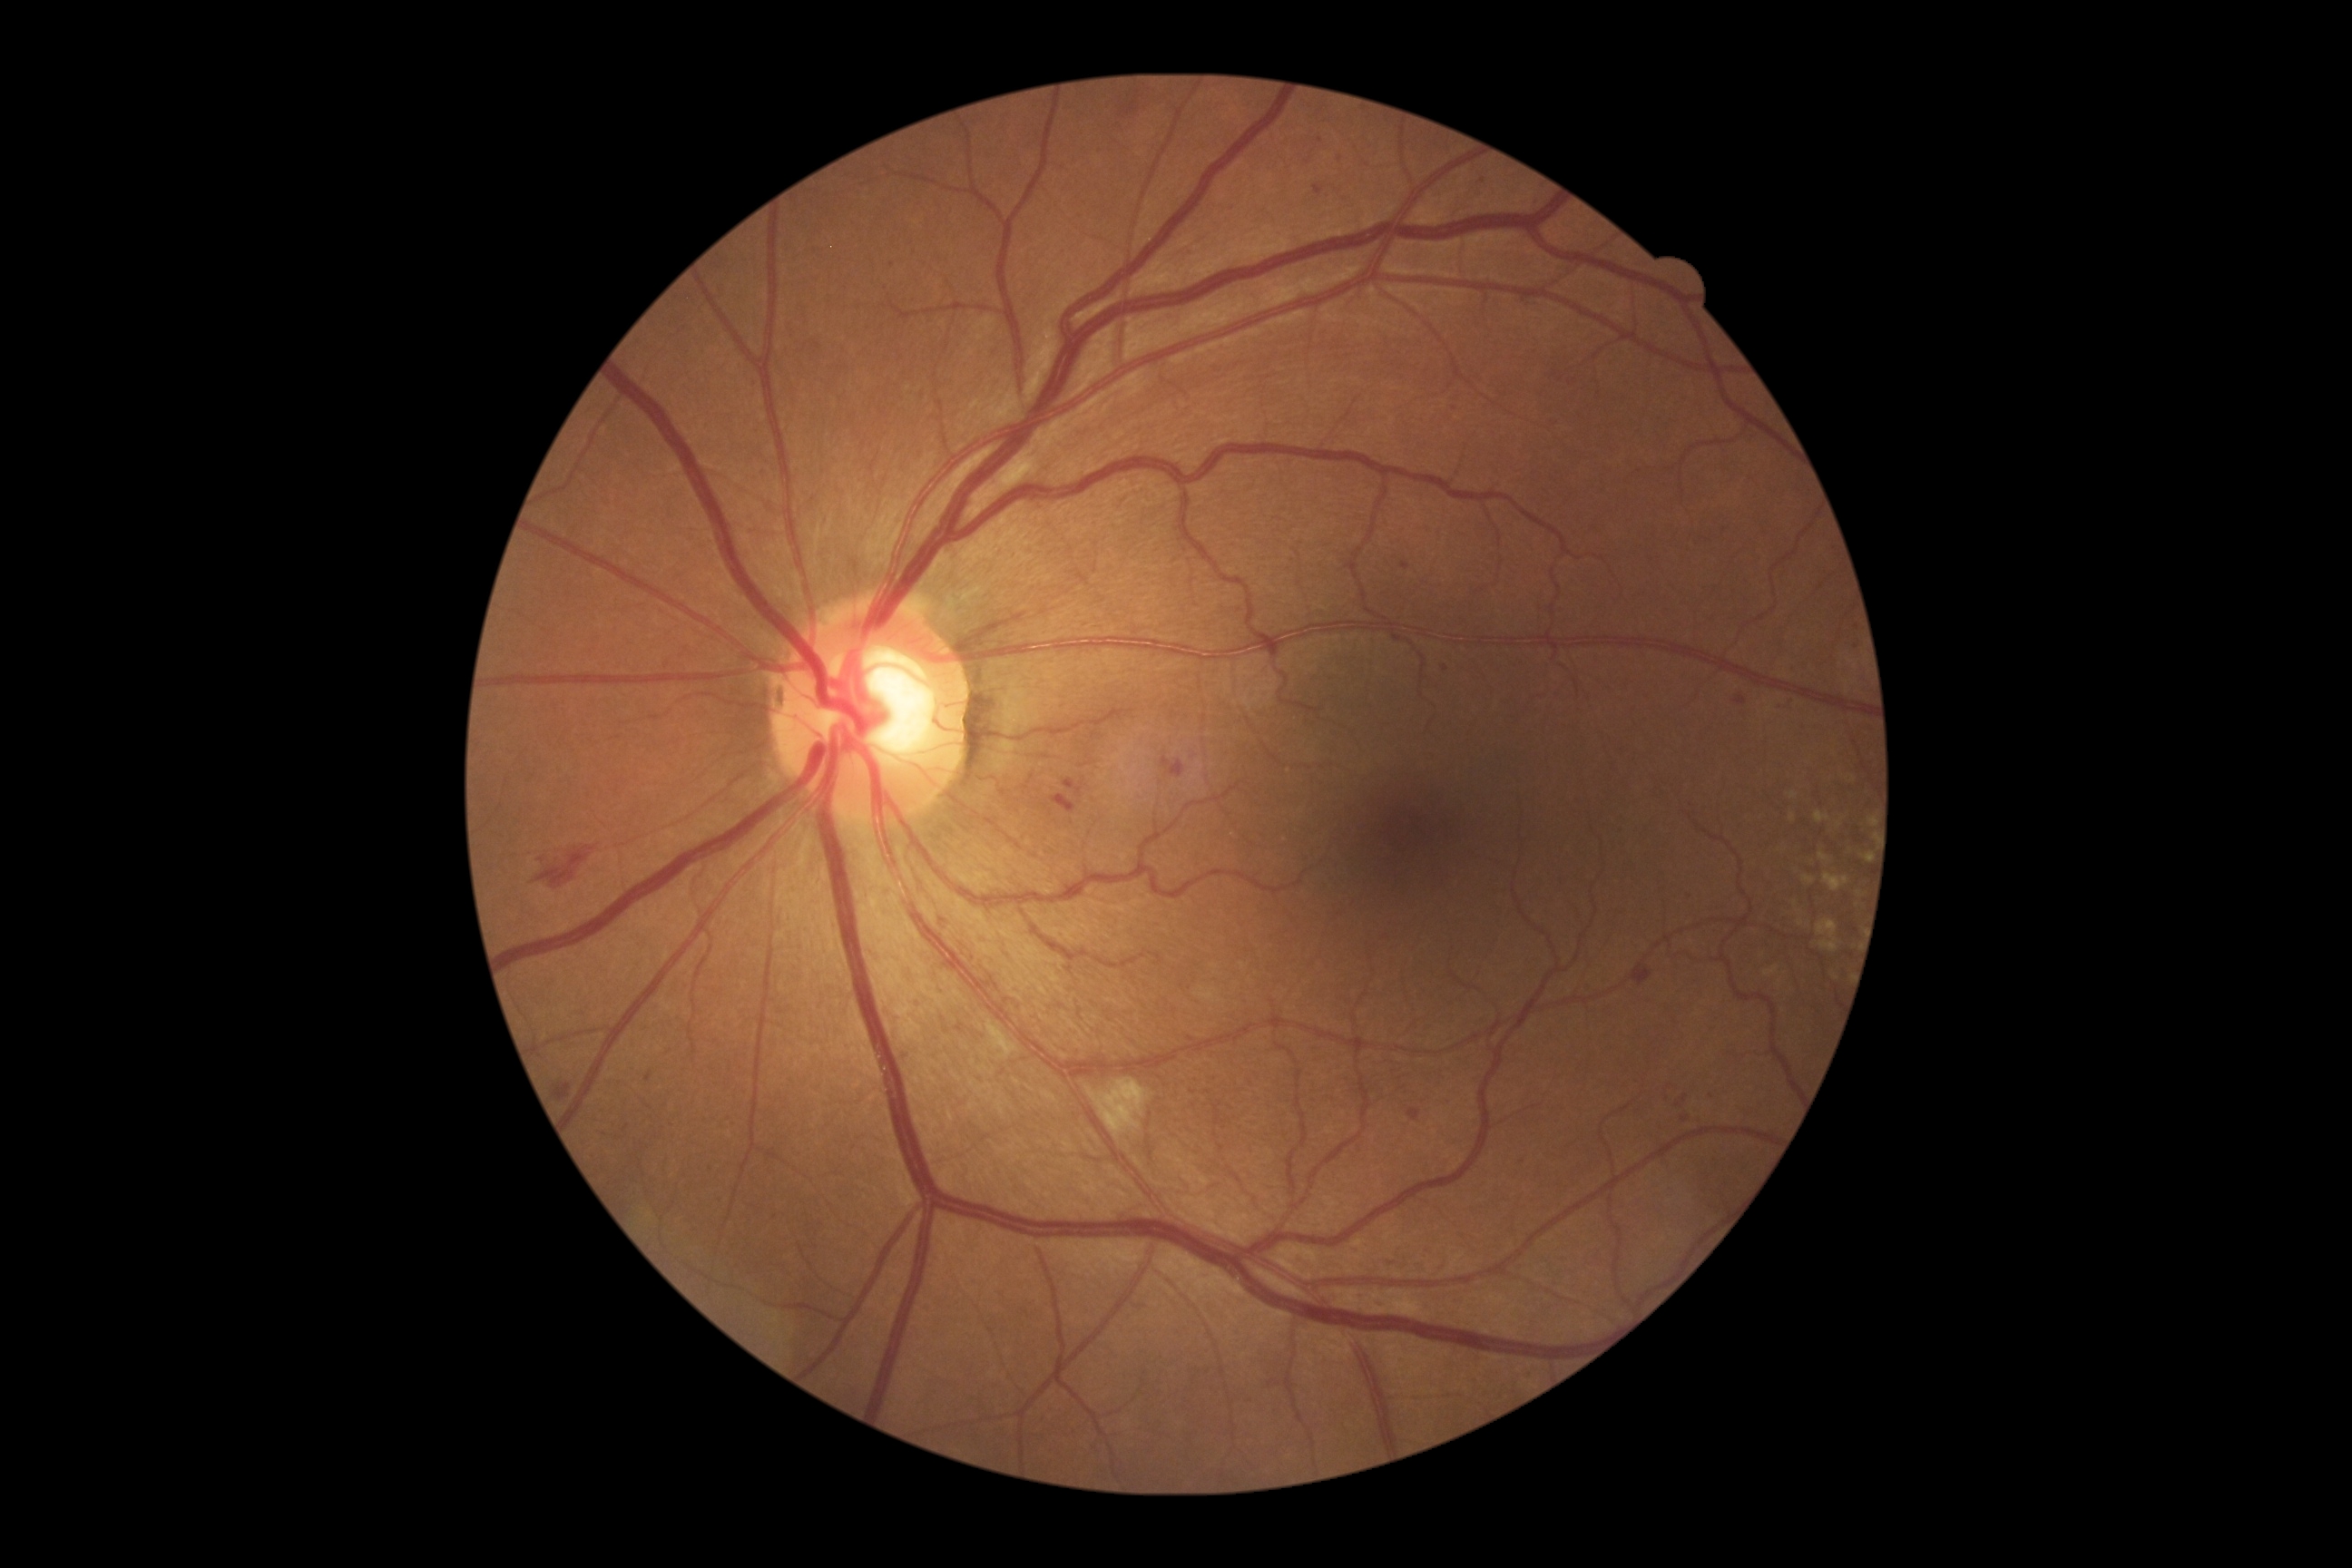

<lesions partial="true">
  <dr_grade>2</dr_grade>
  <ex />
  <he>Rect(1052, 796, 1077, 814), Rect(1064, 779, 1083, 798), Rect(1161, 758, 1186, 779), Rect(1631, 961, 1652, 986), Rect(553, 1084, 571, 1102), Rect(937, 917, 950, 928), Rect(536, 847, 598, 888)</he>
  <ma partial="true">Rect(1313, 184, 1326, 195), Rect(1471, 195, 1480, 202), Rect(1402, 562, 1411, 571), Rect(1407, 1108, 1422, 1122), Rect(1351, 1246, 1362, 1255), Rect(710, 1168, 718, 1175)</ma>
  <ma_small_approx>{"x": 1857, "y": 647}, {"x": 1686, "y": 1098}, {"x": 893, "y": 265}, {"x": 1321, "y": 141}, {"x": 1340, "y": 159}, {"x": 1483, "y": 180}, {"x": 1536, "y": 204}</ma_small_approx>
  <se>Rect(1086, 1079, 1150, 1139), Rect(986, 1021, 1019, 1061), Rect(999, 451, 1037, 489)</se>
</lesions>